45° FOV
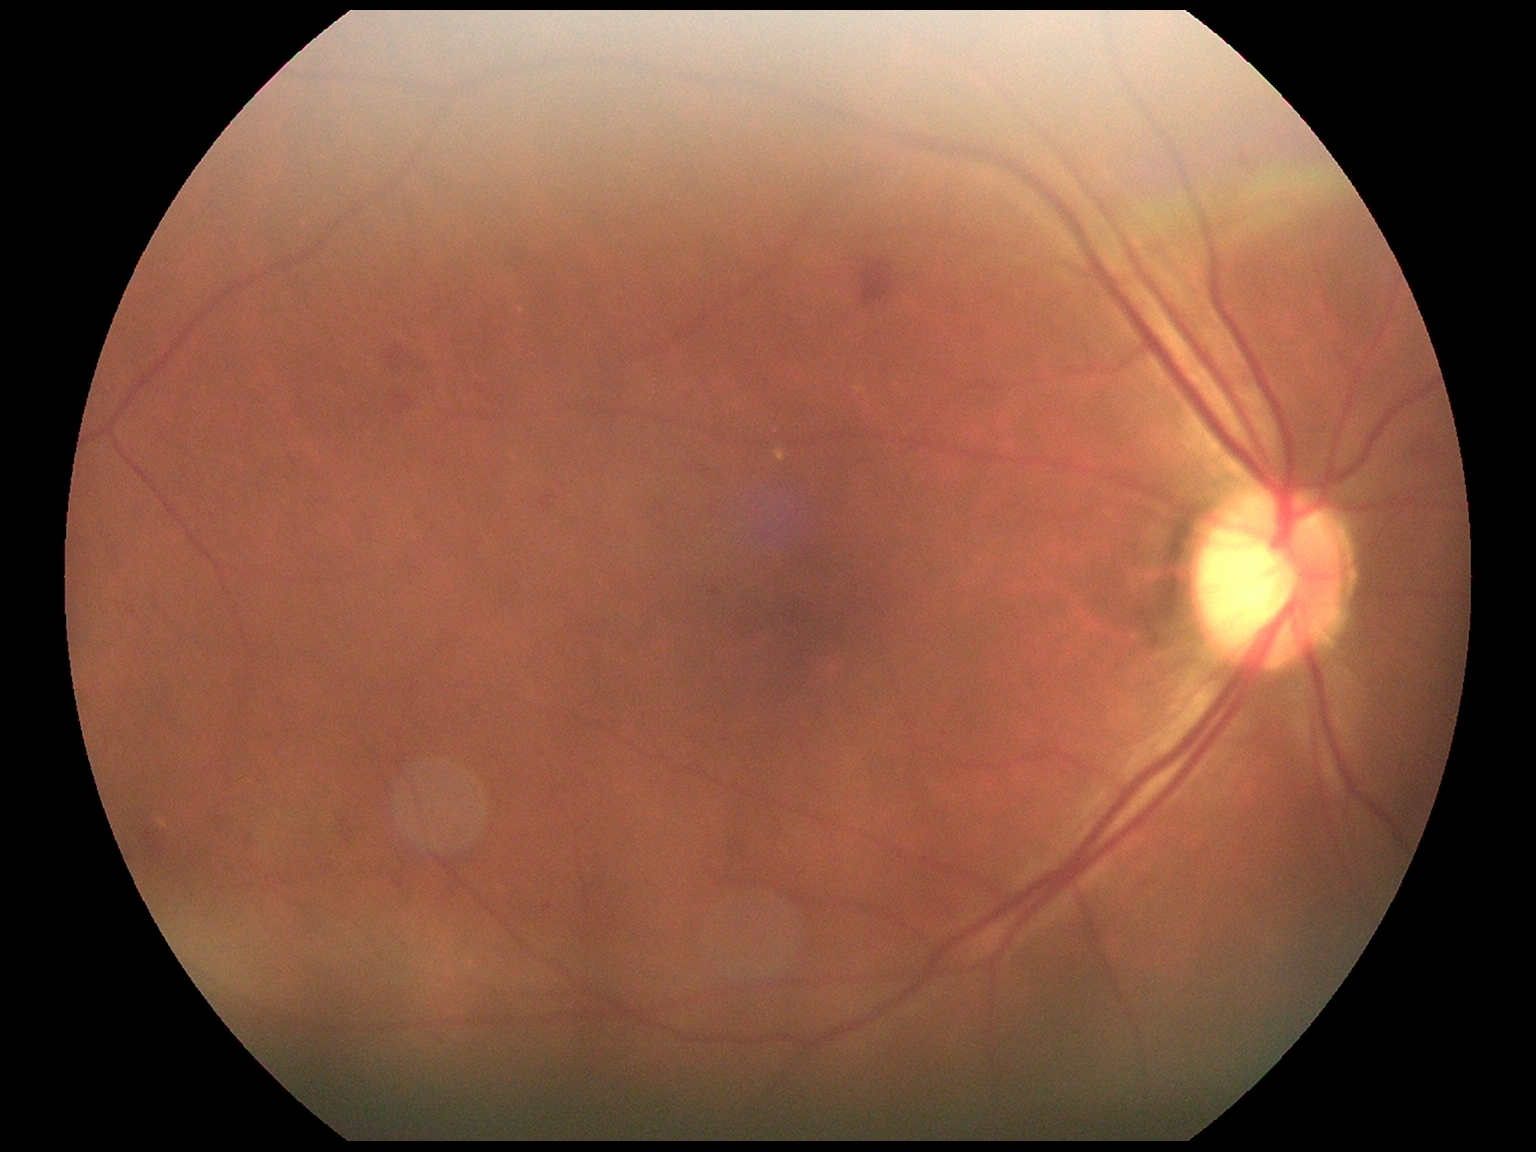 Retinopathy is moderate non-proliferative diabetic retinopathy (grade 2).